45-degree field of view · no pharmacologic dilation.
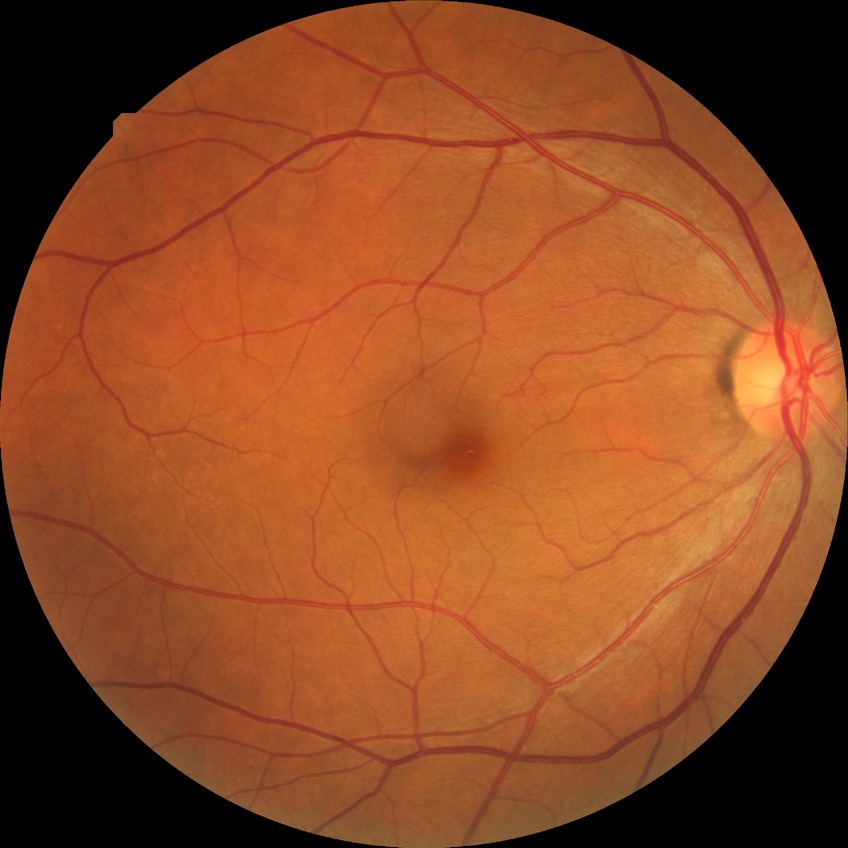

DR = NDR, DR impression = no DR findings.